2048x1536px; fundus photo; Forus 3Nethra Classic fundus camera: 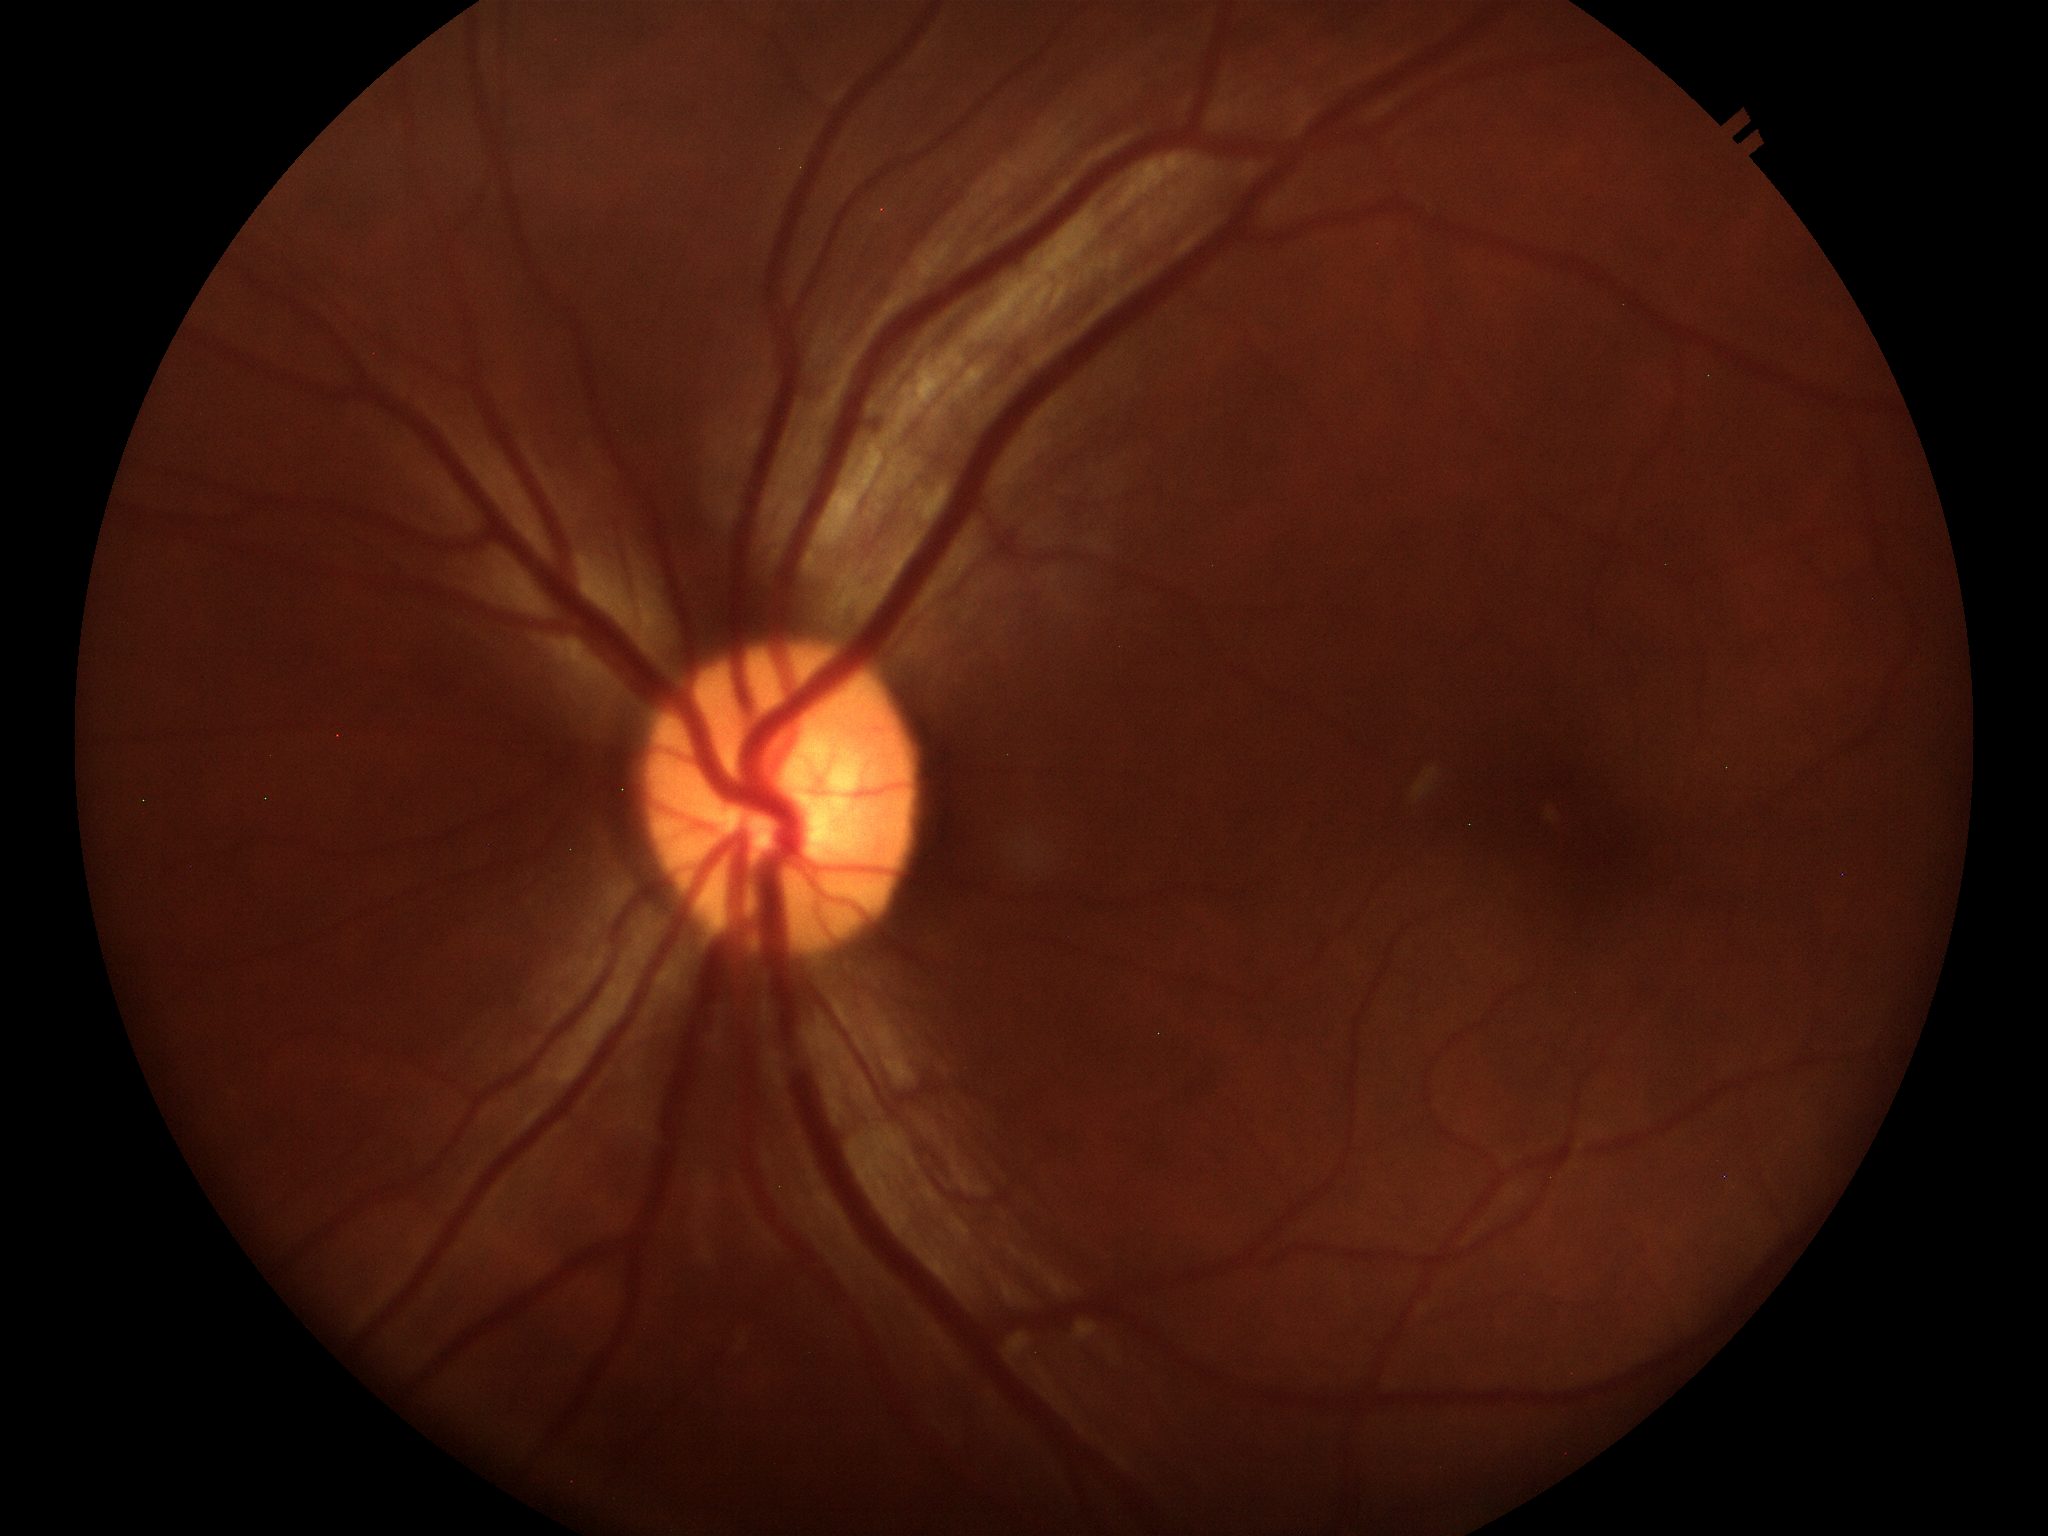
vertical C/D ratio: 0.53
Glaucoma assessment: no suspicious findings